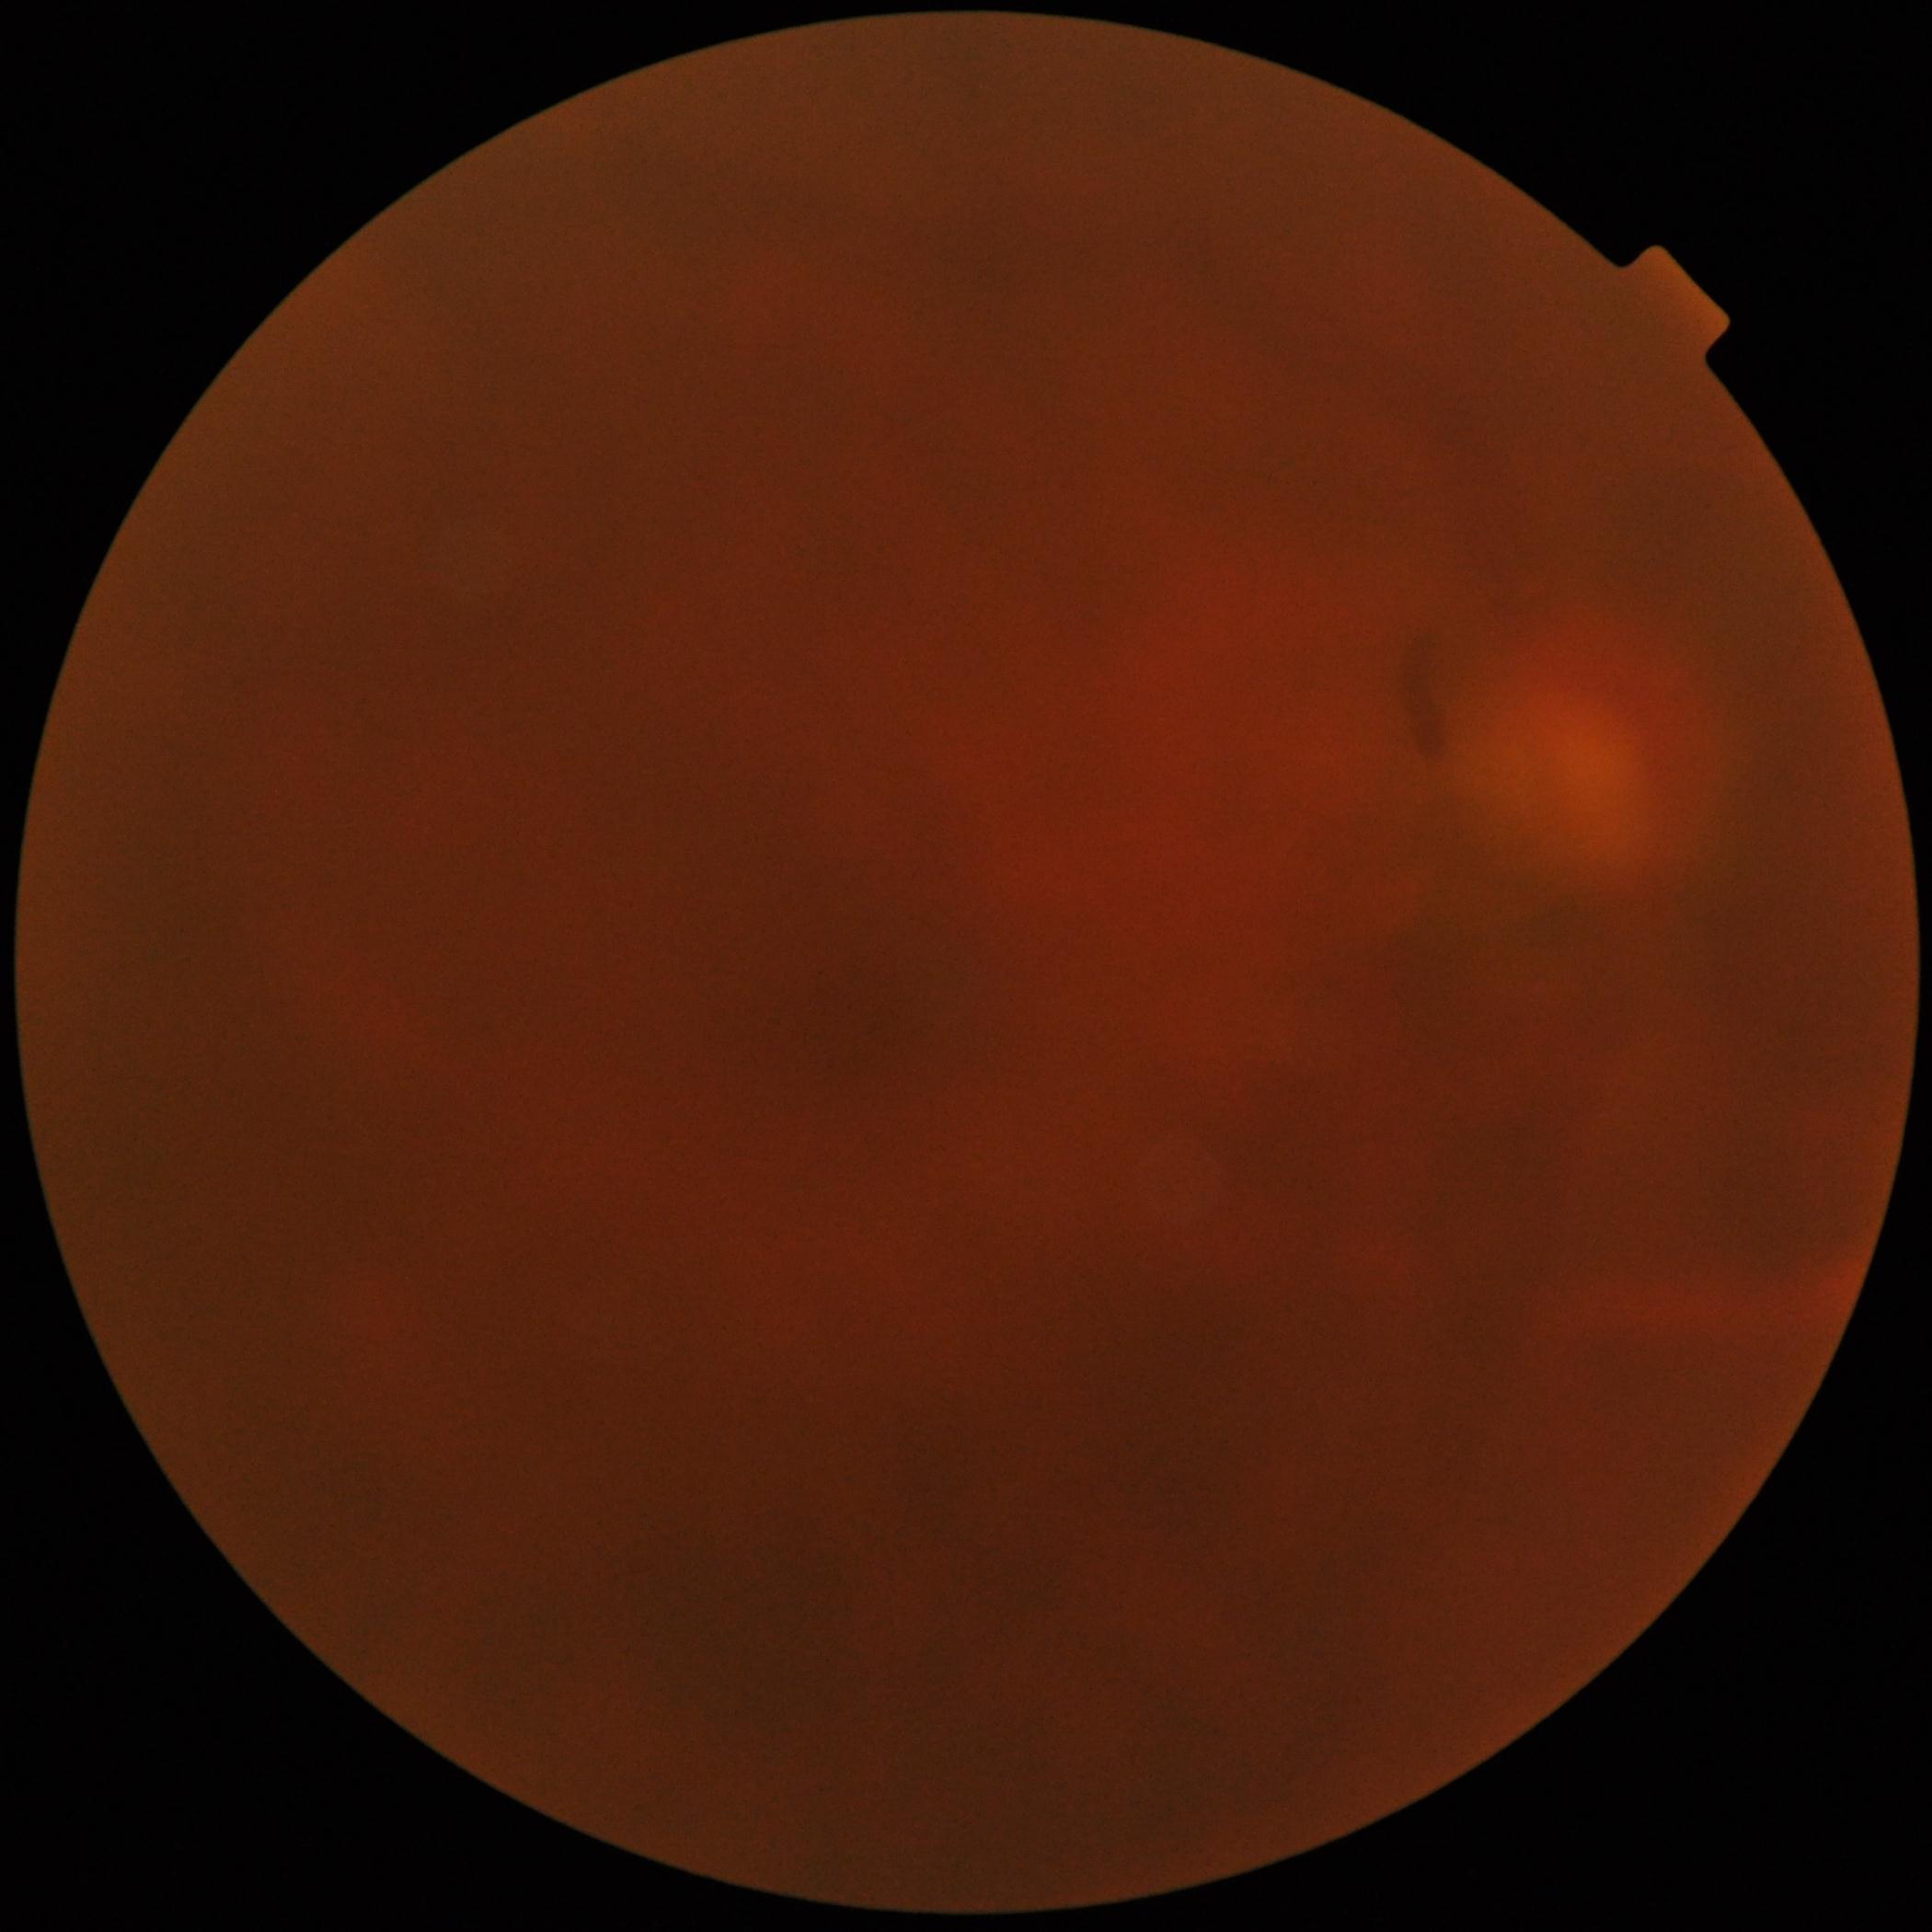
image quality = insufficient, DR = ungradable.